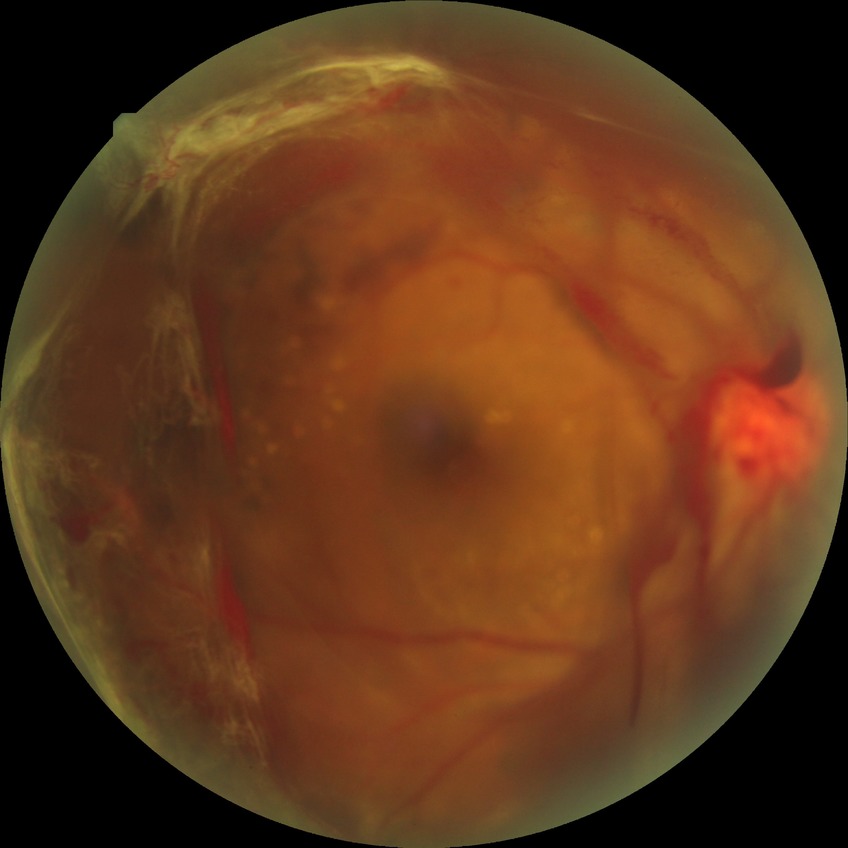 Diabetic retinopathy stage is proliferative diabetic retinopathy.